Without pupil dilation; retinal fundus photograph:
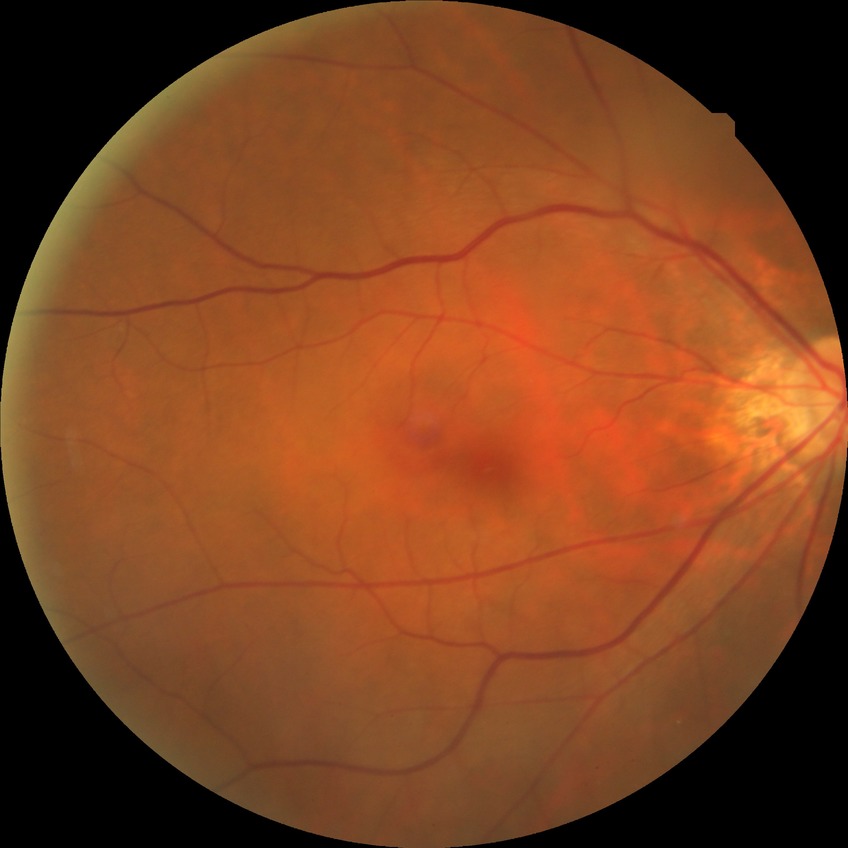
diabetic retinopathy (DR)@NDR (no diabetic retinopathy).